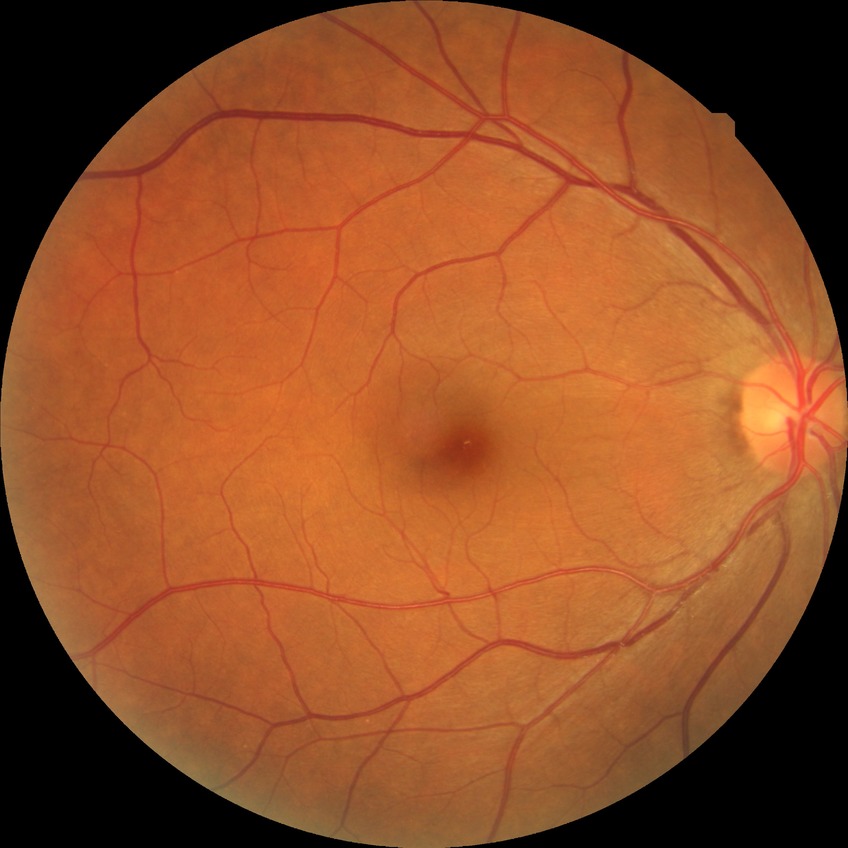
No diabetic retinal disease findings. DR stage is NDR.